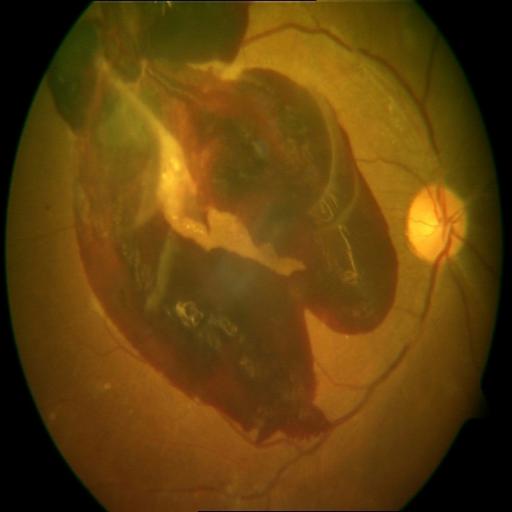 Impression: preretinal hemorrhage.